Wide-field fundus photograph from neonatal ROP screening; image size 1440x1080; Natus RetCam Envision, 130° FOV:
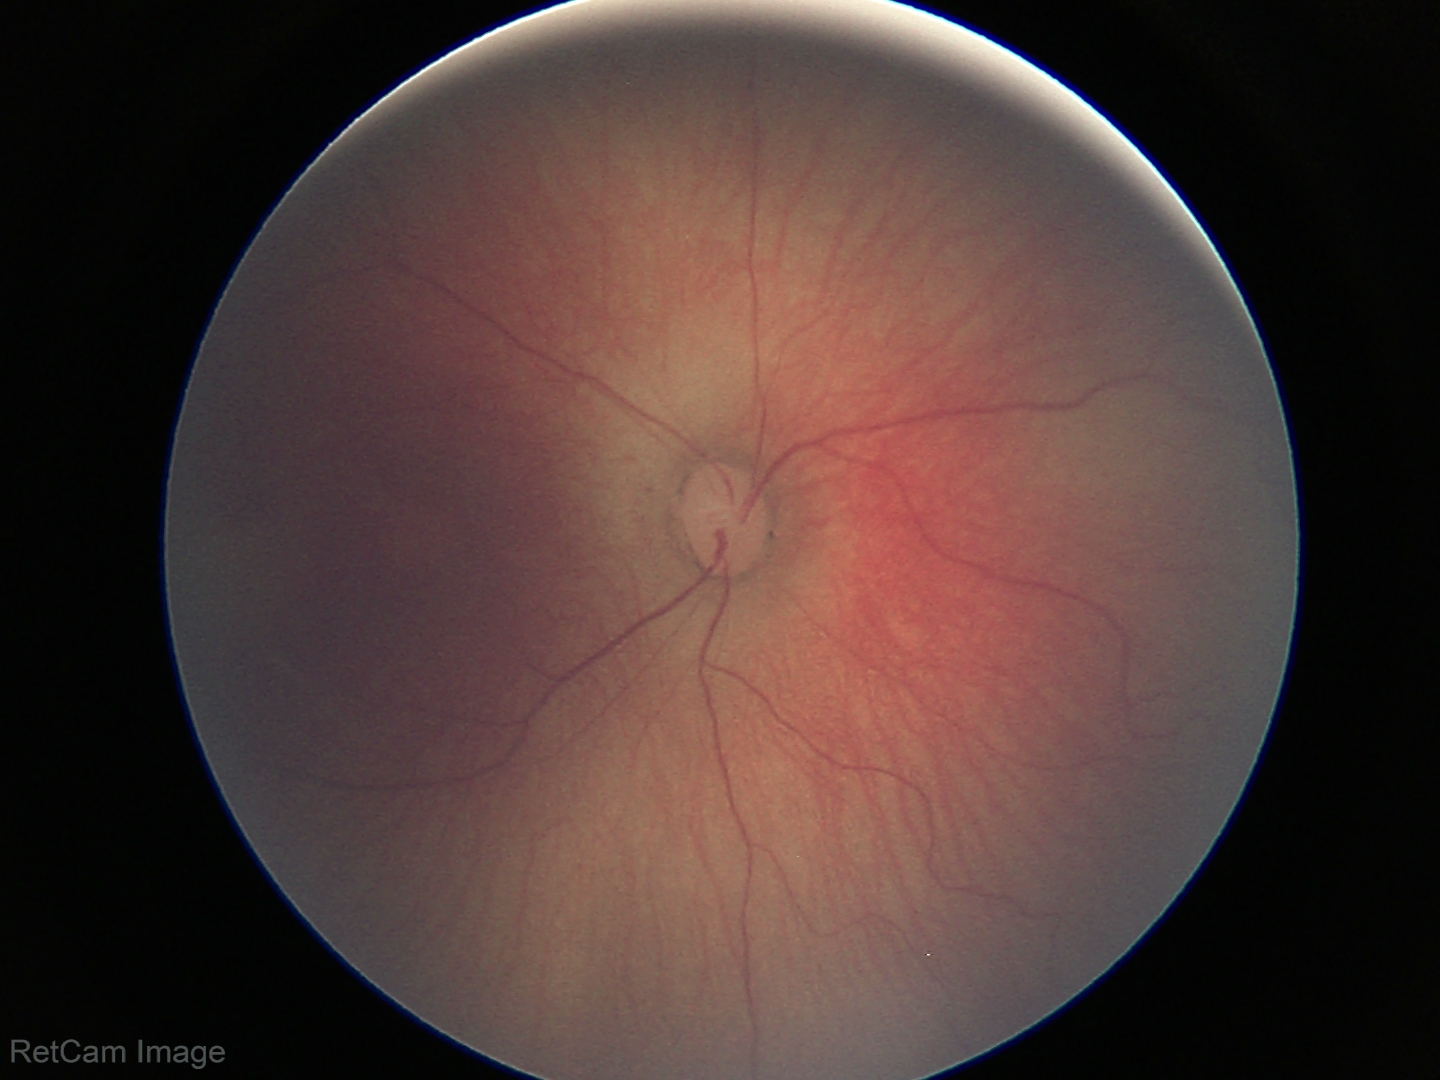
Screening examination consistent with retinopathy of prematurity stage 1.